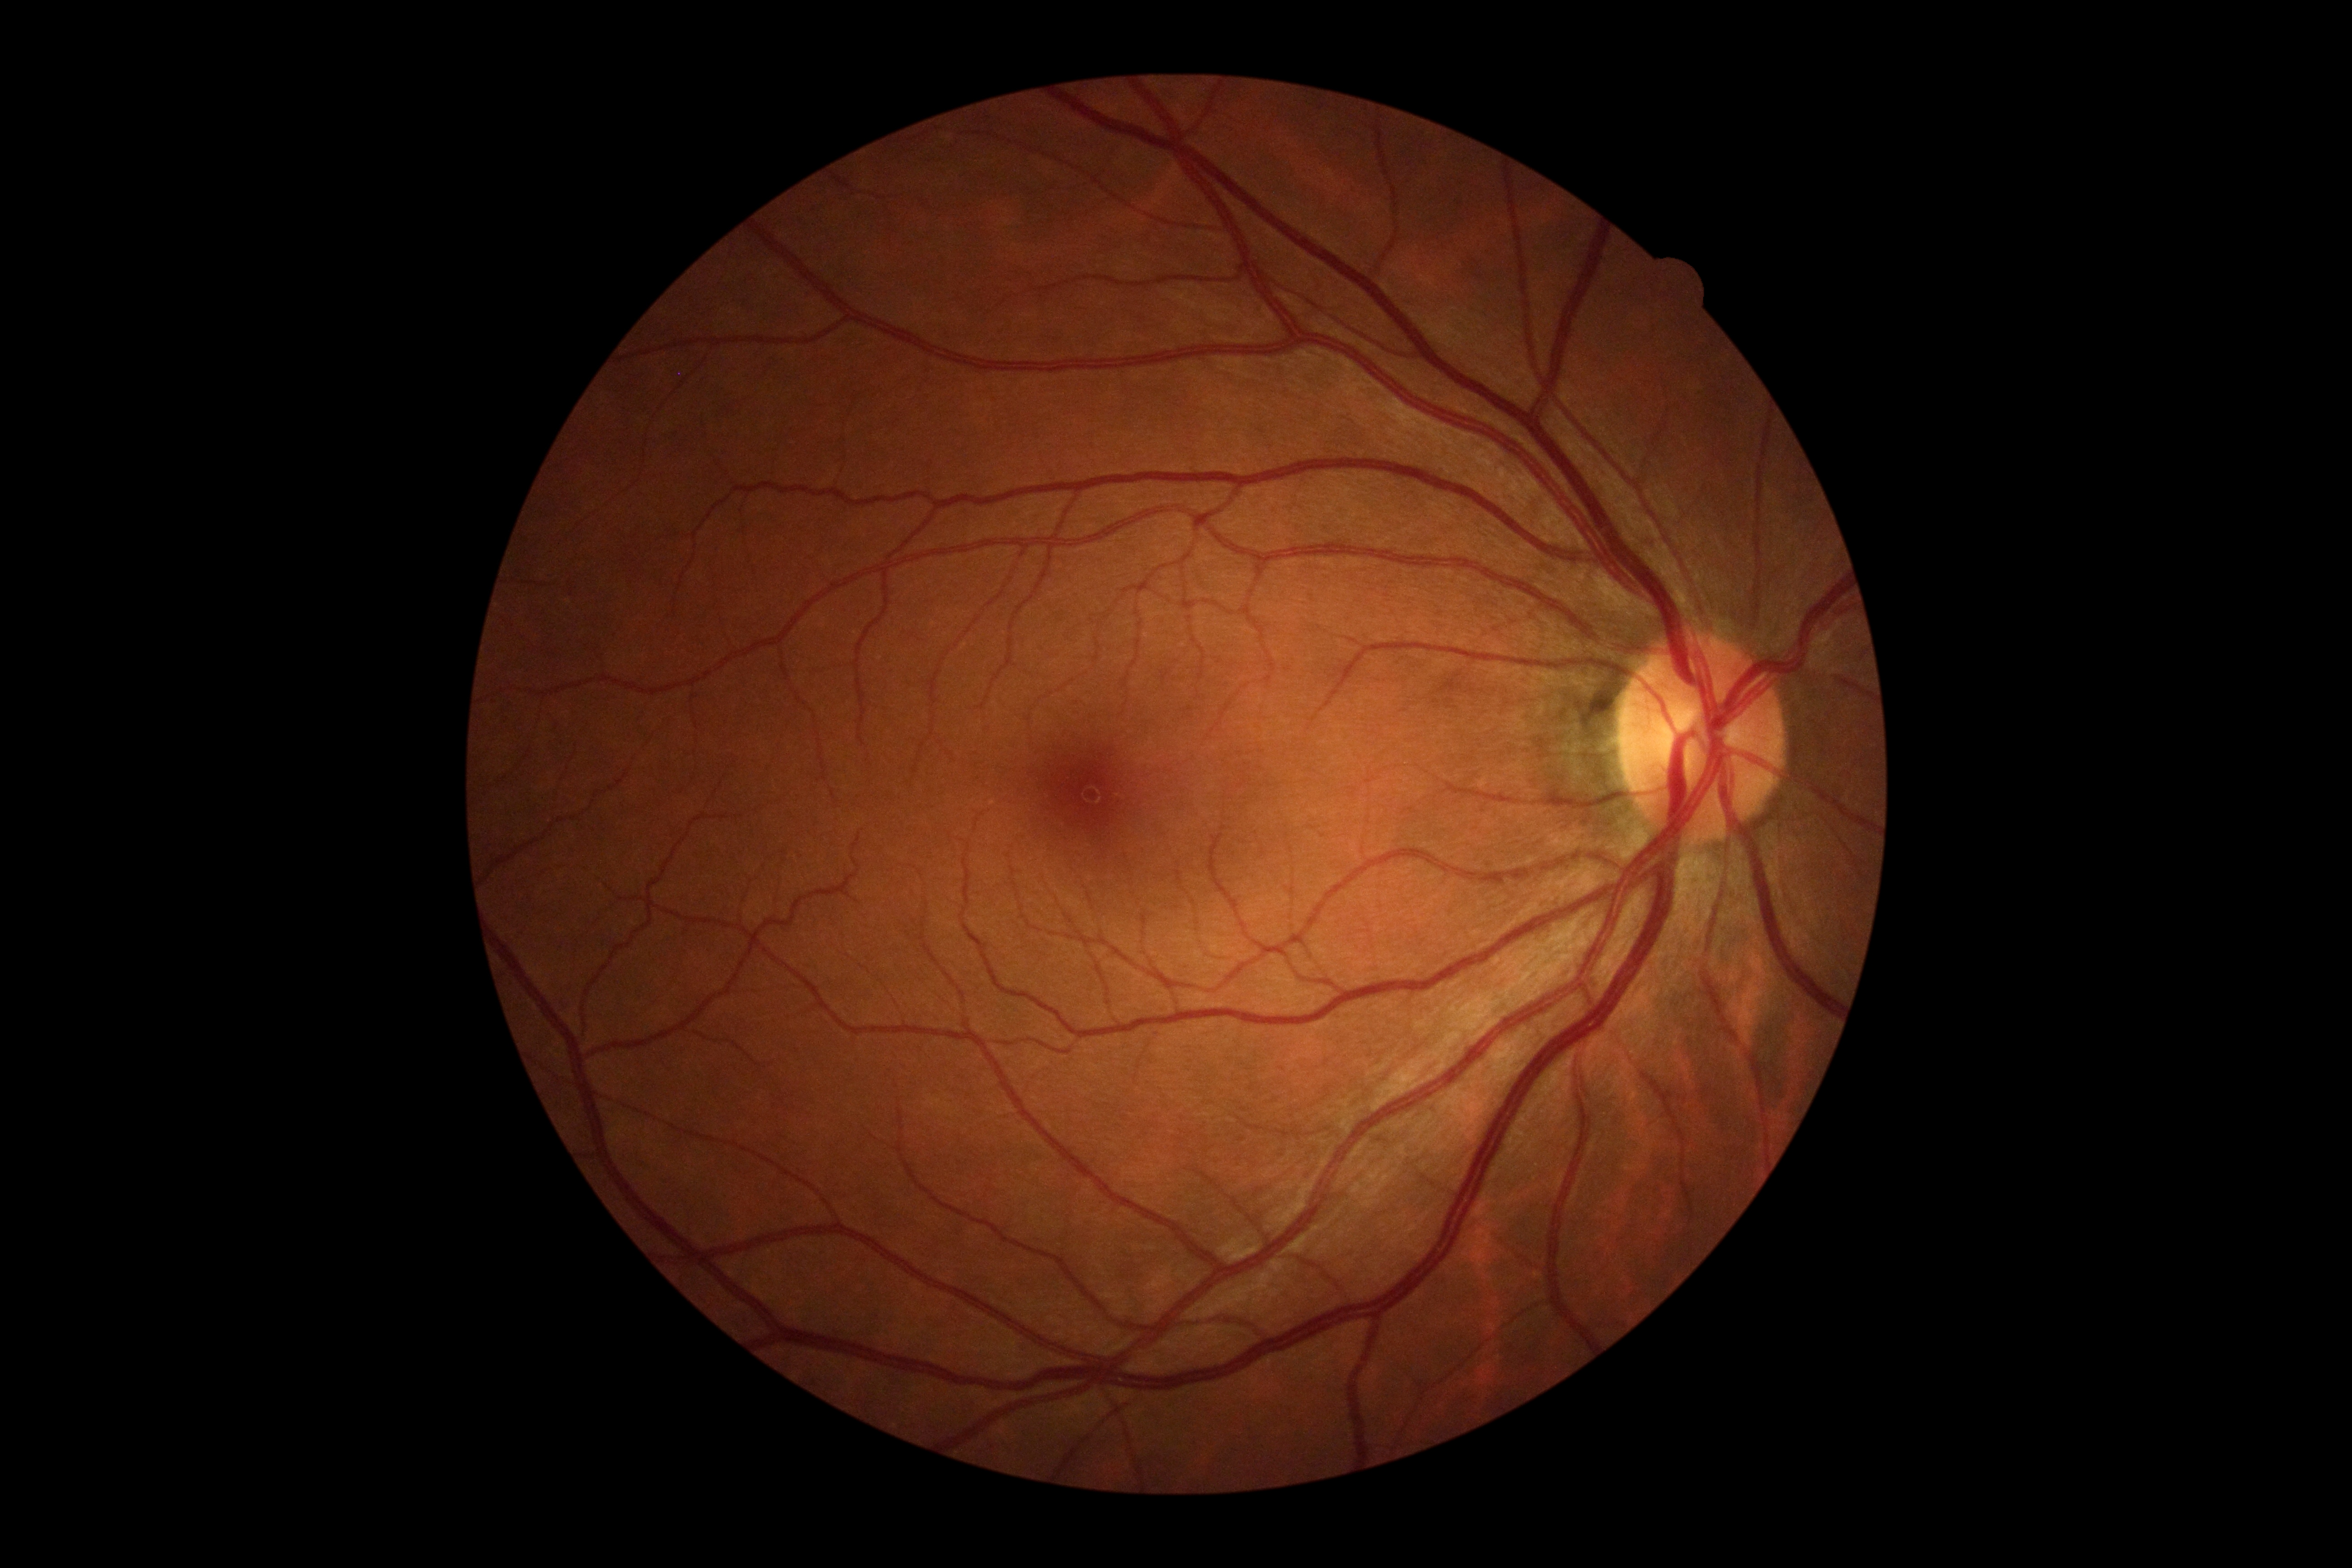

Diabetic retinopathy (DR): grade 0 (no apparent retinopathy).